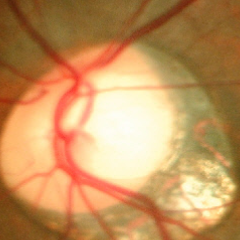
Glaucoma status = early glaucomatous optic neuropathy.